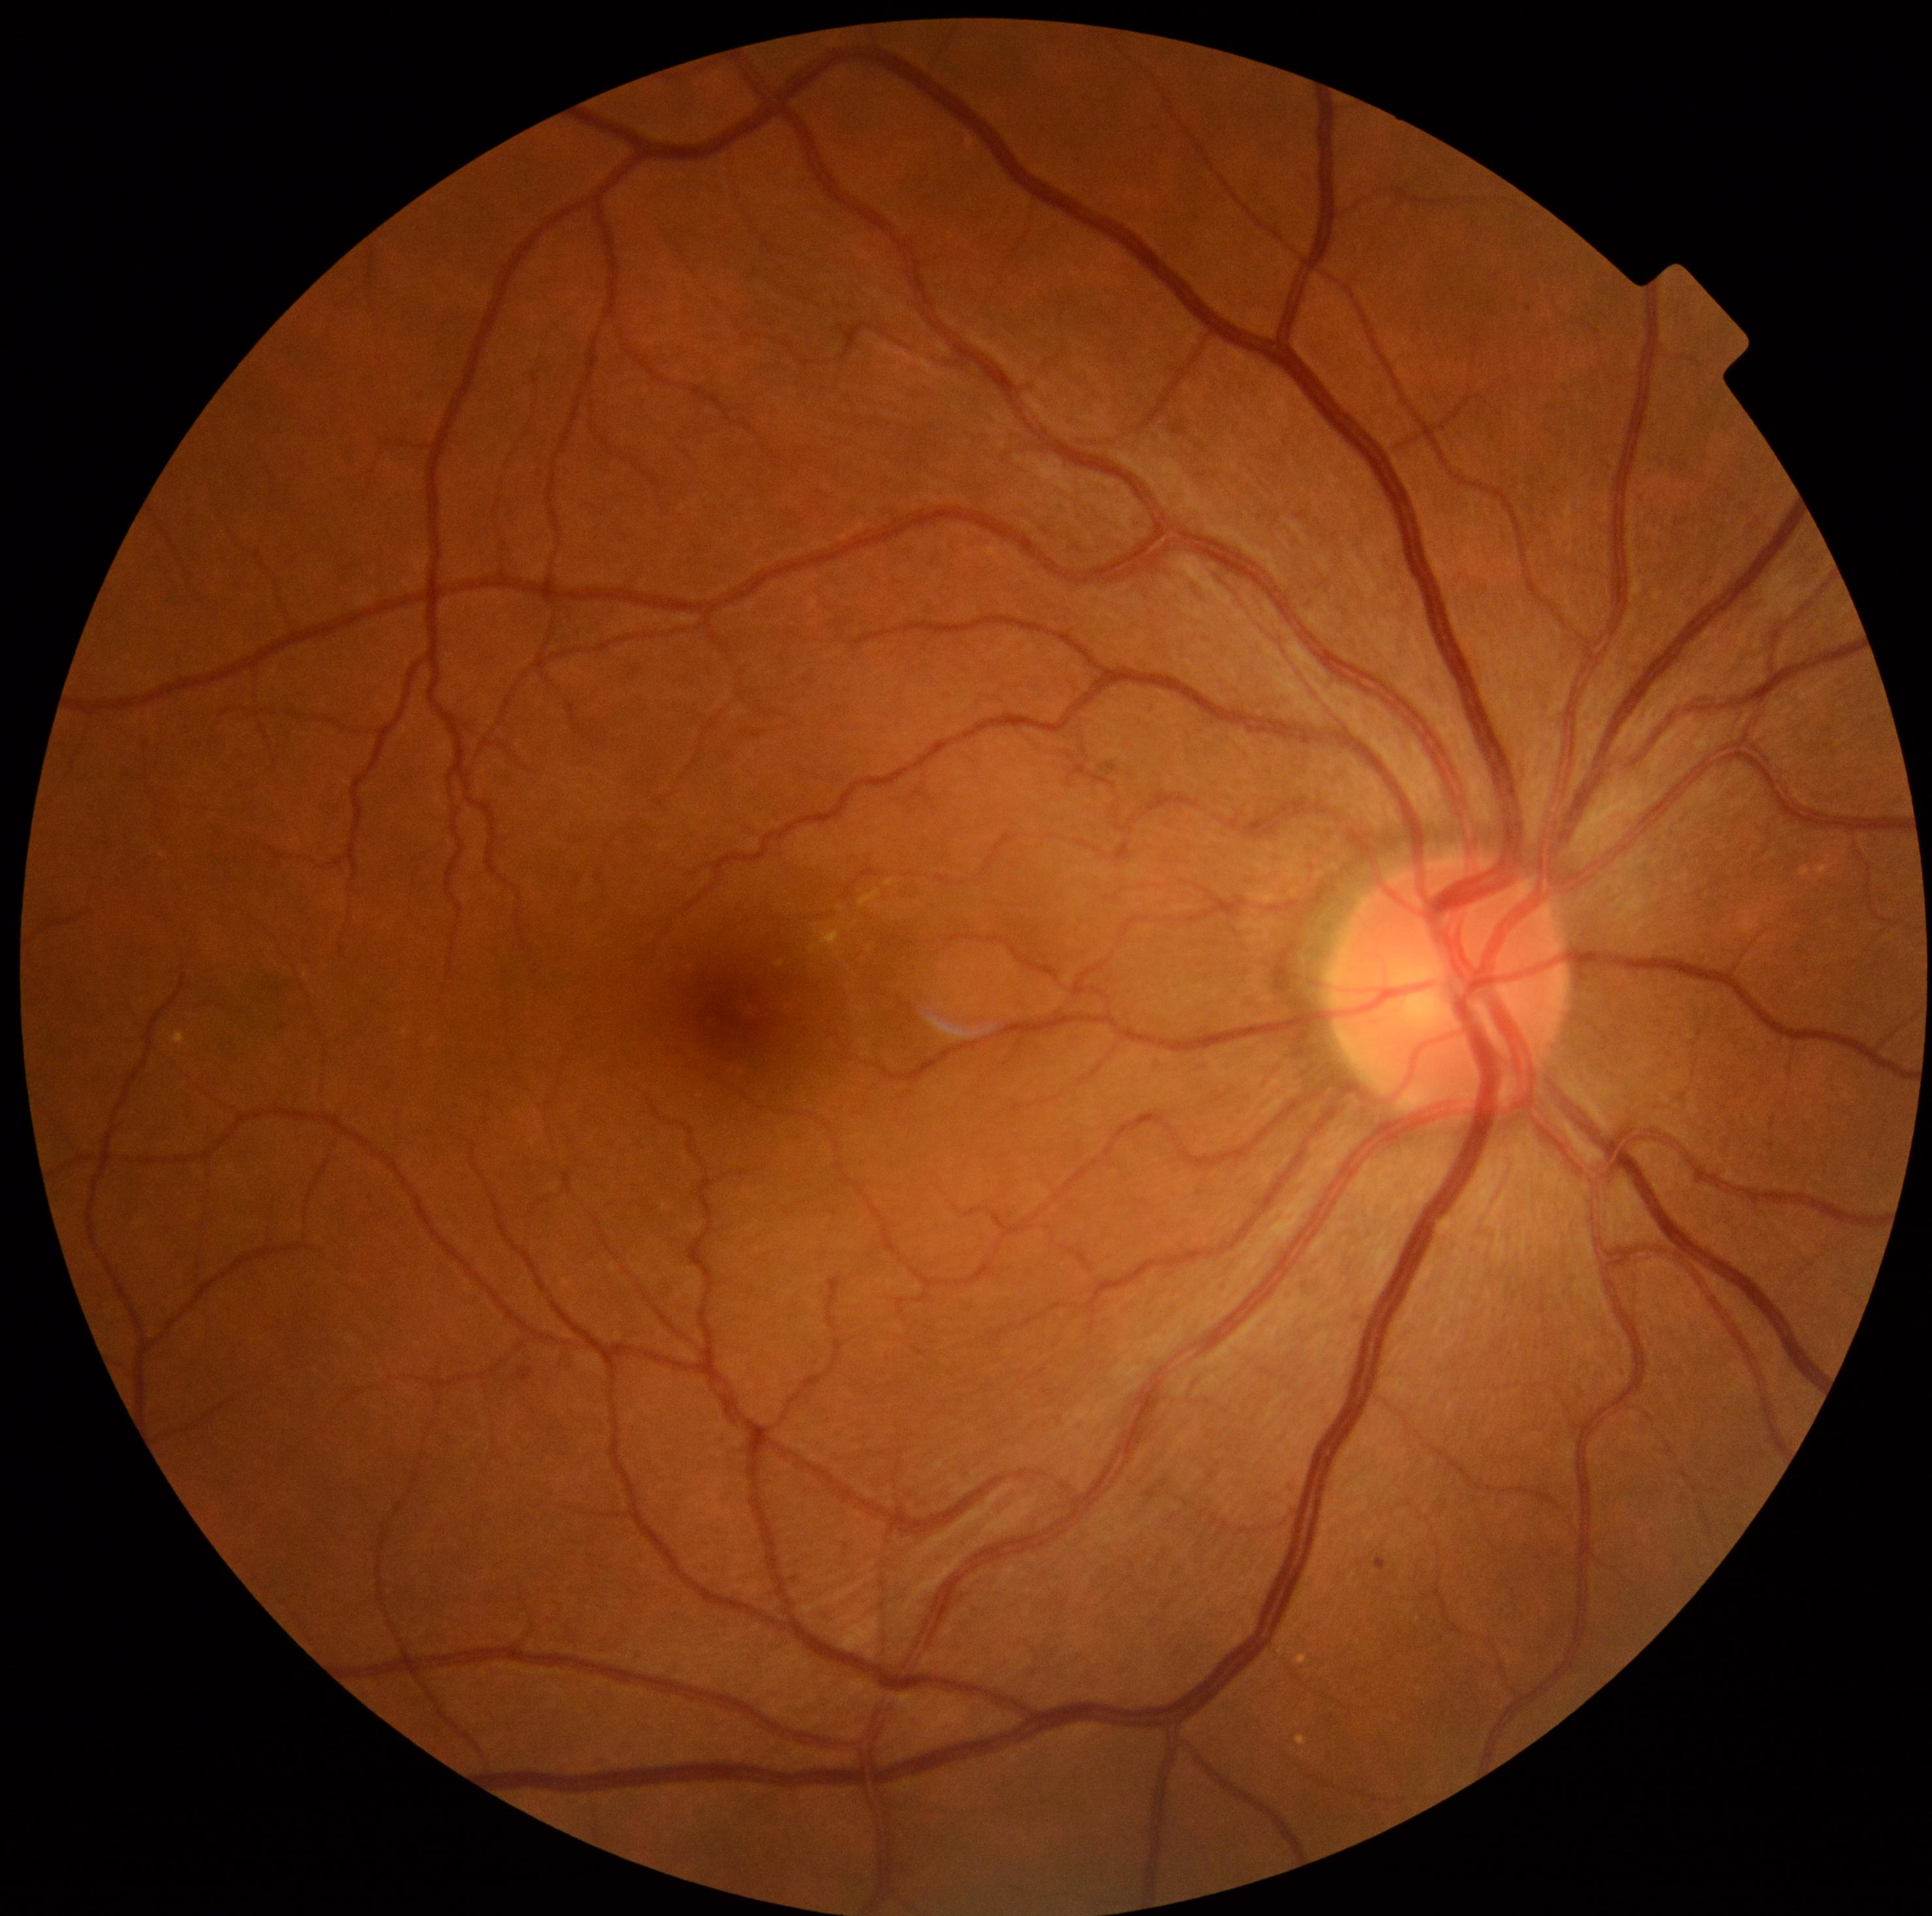
DR grade: 2 (moderate NPDR) — more than just microaneurysms but less than severe NPDR
HEs = not present
SEs = not present
EXs = l=809, t=928, r=841, b=954; l=776, t=961, r=785, b=967; l=887, t=880, r=896, b=887; l=860, t=890, r=880, b=907
Small EXs near 840:908
MAs = l=518, t=1368, r=533, b=1381; l=1377, t=1558, r=1387, b=1571
Small MAs near 1529:310